CFP; 1380 by 1382 pixels; FOV: 45 degrees: 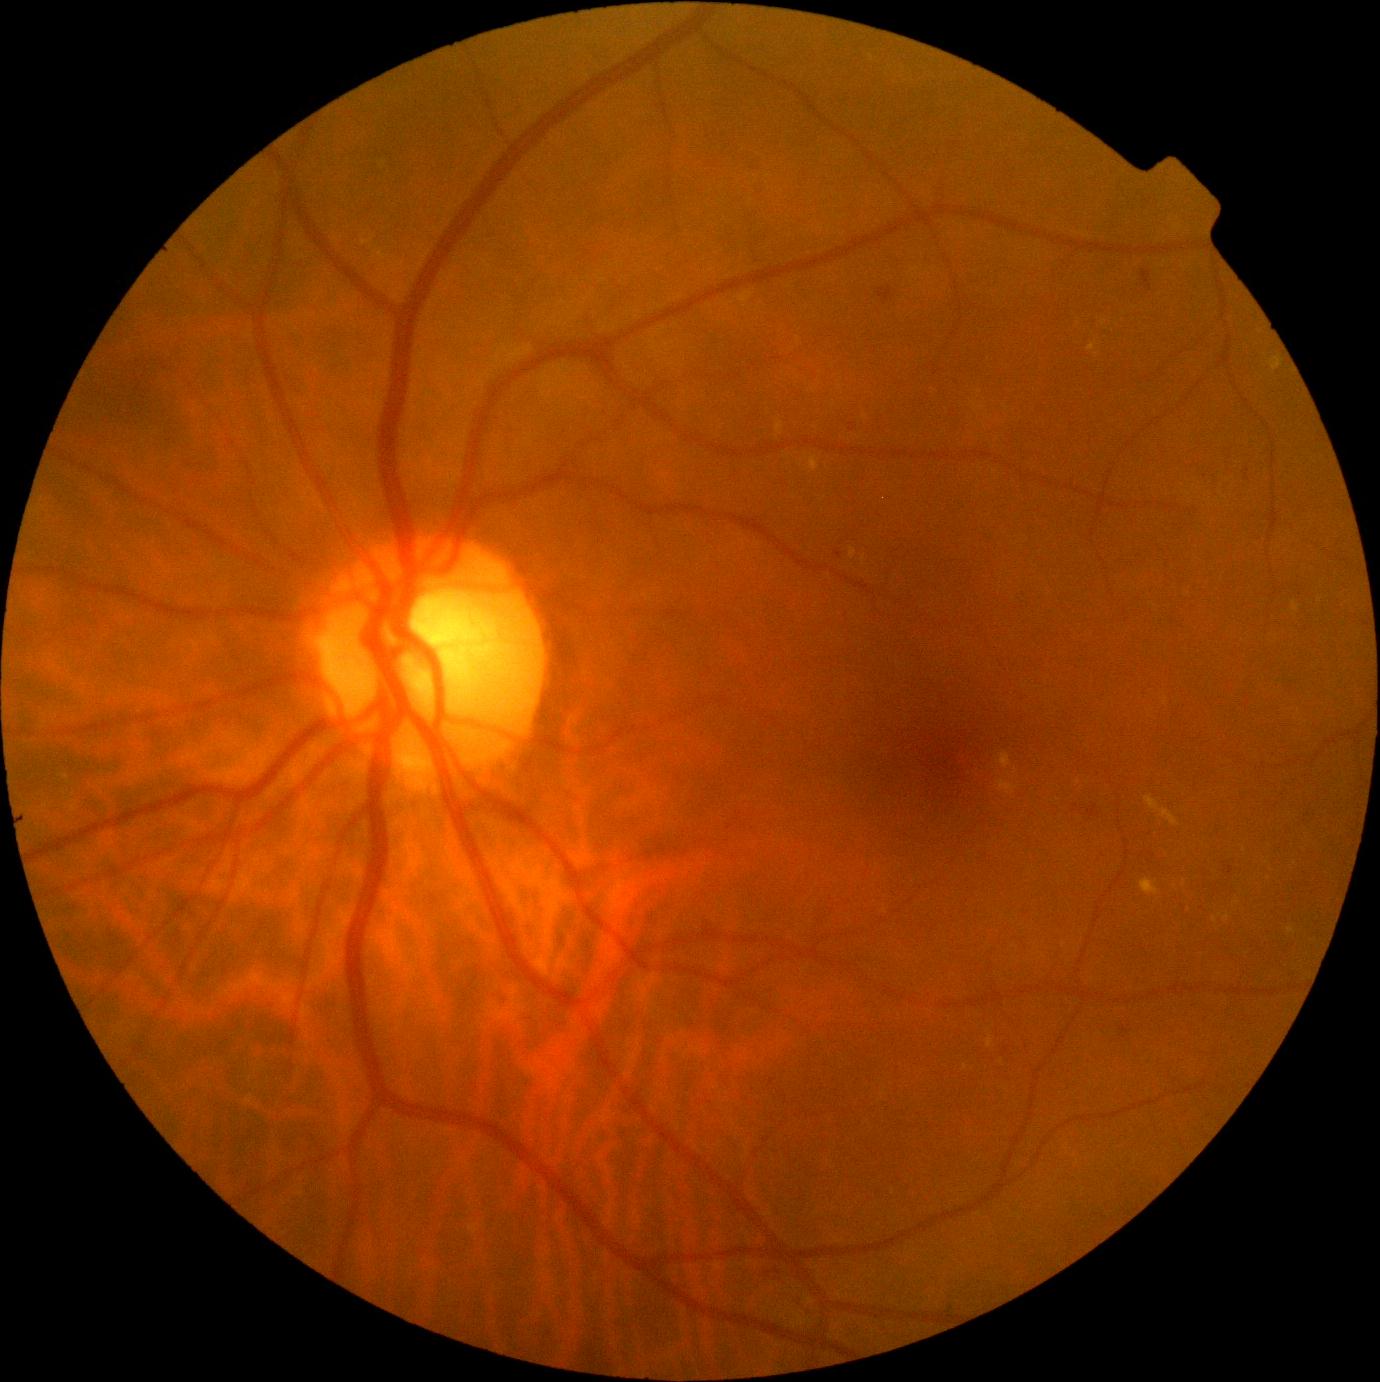 DR stage is 2/4
Representative lesions:
EXs (subset) = BBox(987, 1036, 995, 1048) | BBox(1140, 878, 1159, 896) | BBox(999, 752, 1012, 769) | BBox(1224, 913, 1231, 921) | BBox(1292, 601, 1299, 612) | BBox(1271, 357, 1283, 371) | BBox(775, 421, 785, 435)
Small EXs approximately at 1097/355 | 1220/915 | 864/560 | 1215/919 | 1237/903 | 73/809 | 1001/1062 | 1079/782